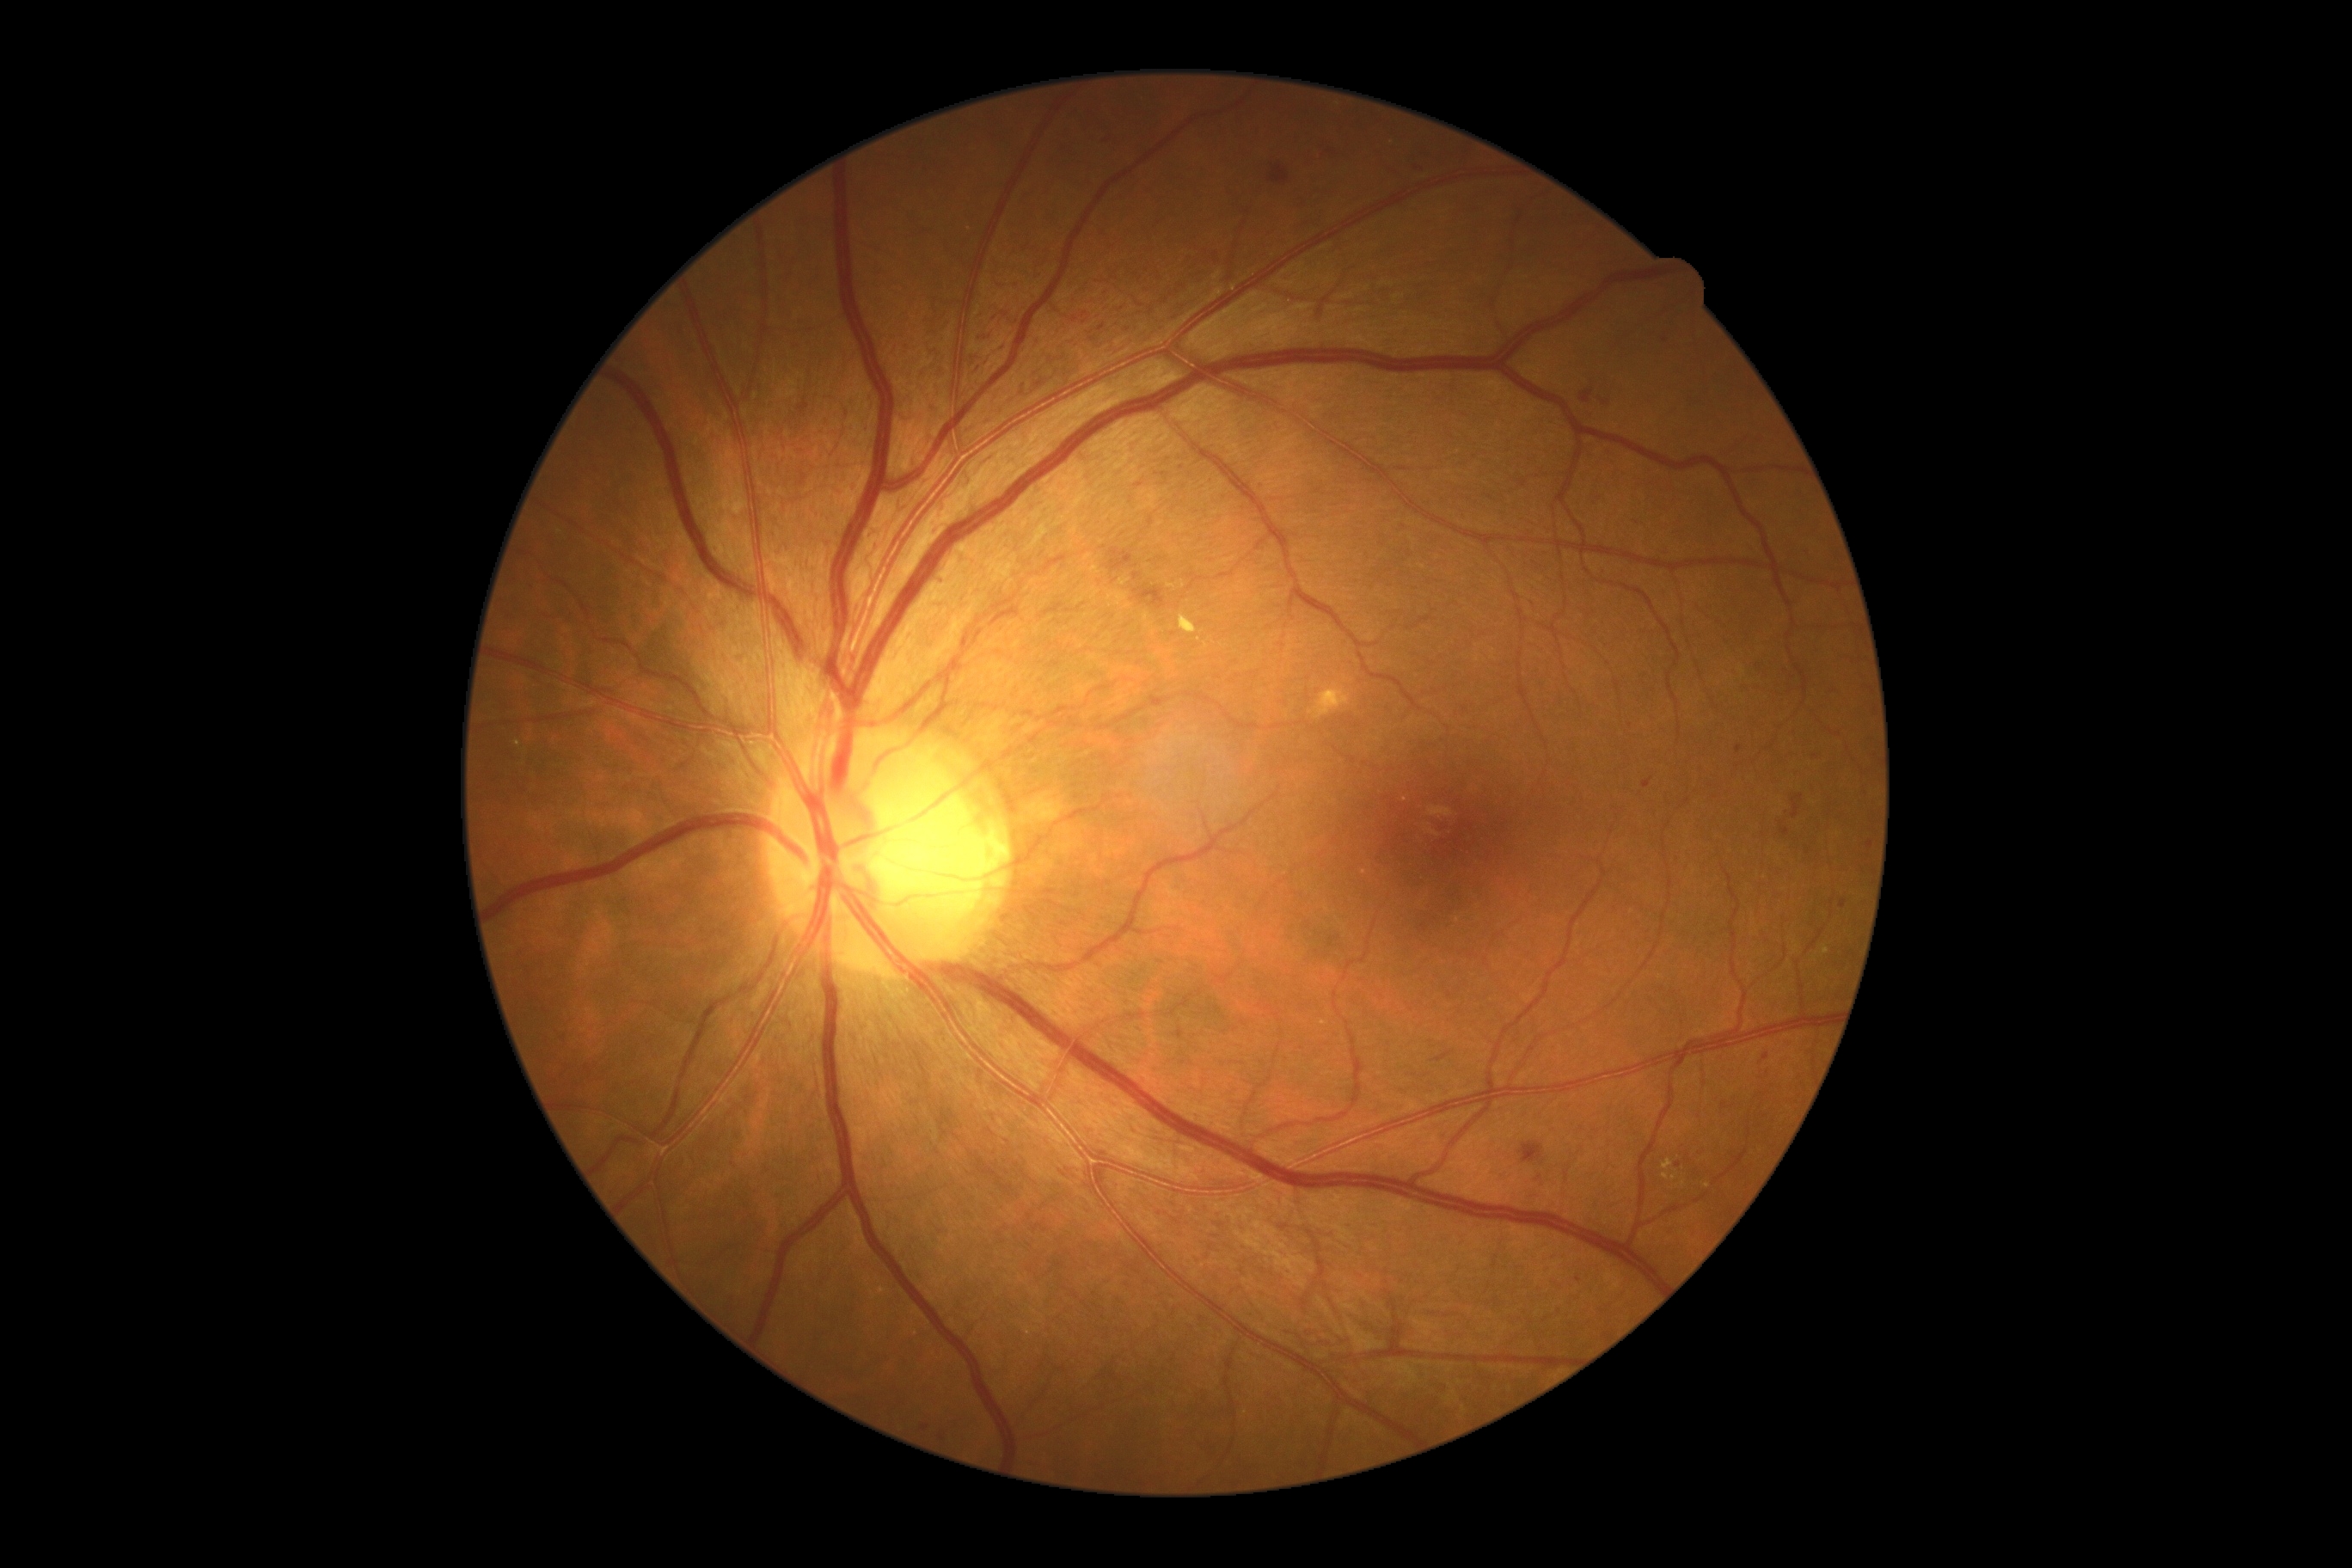
Diabetic retinopathy grade is 3.